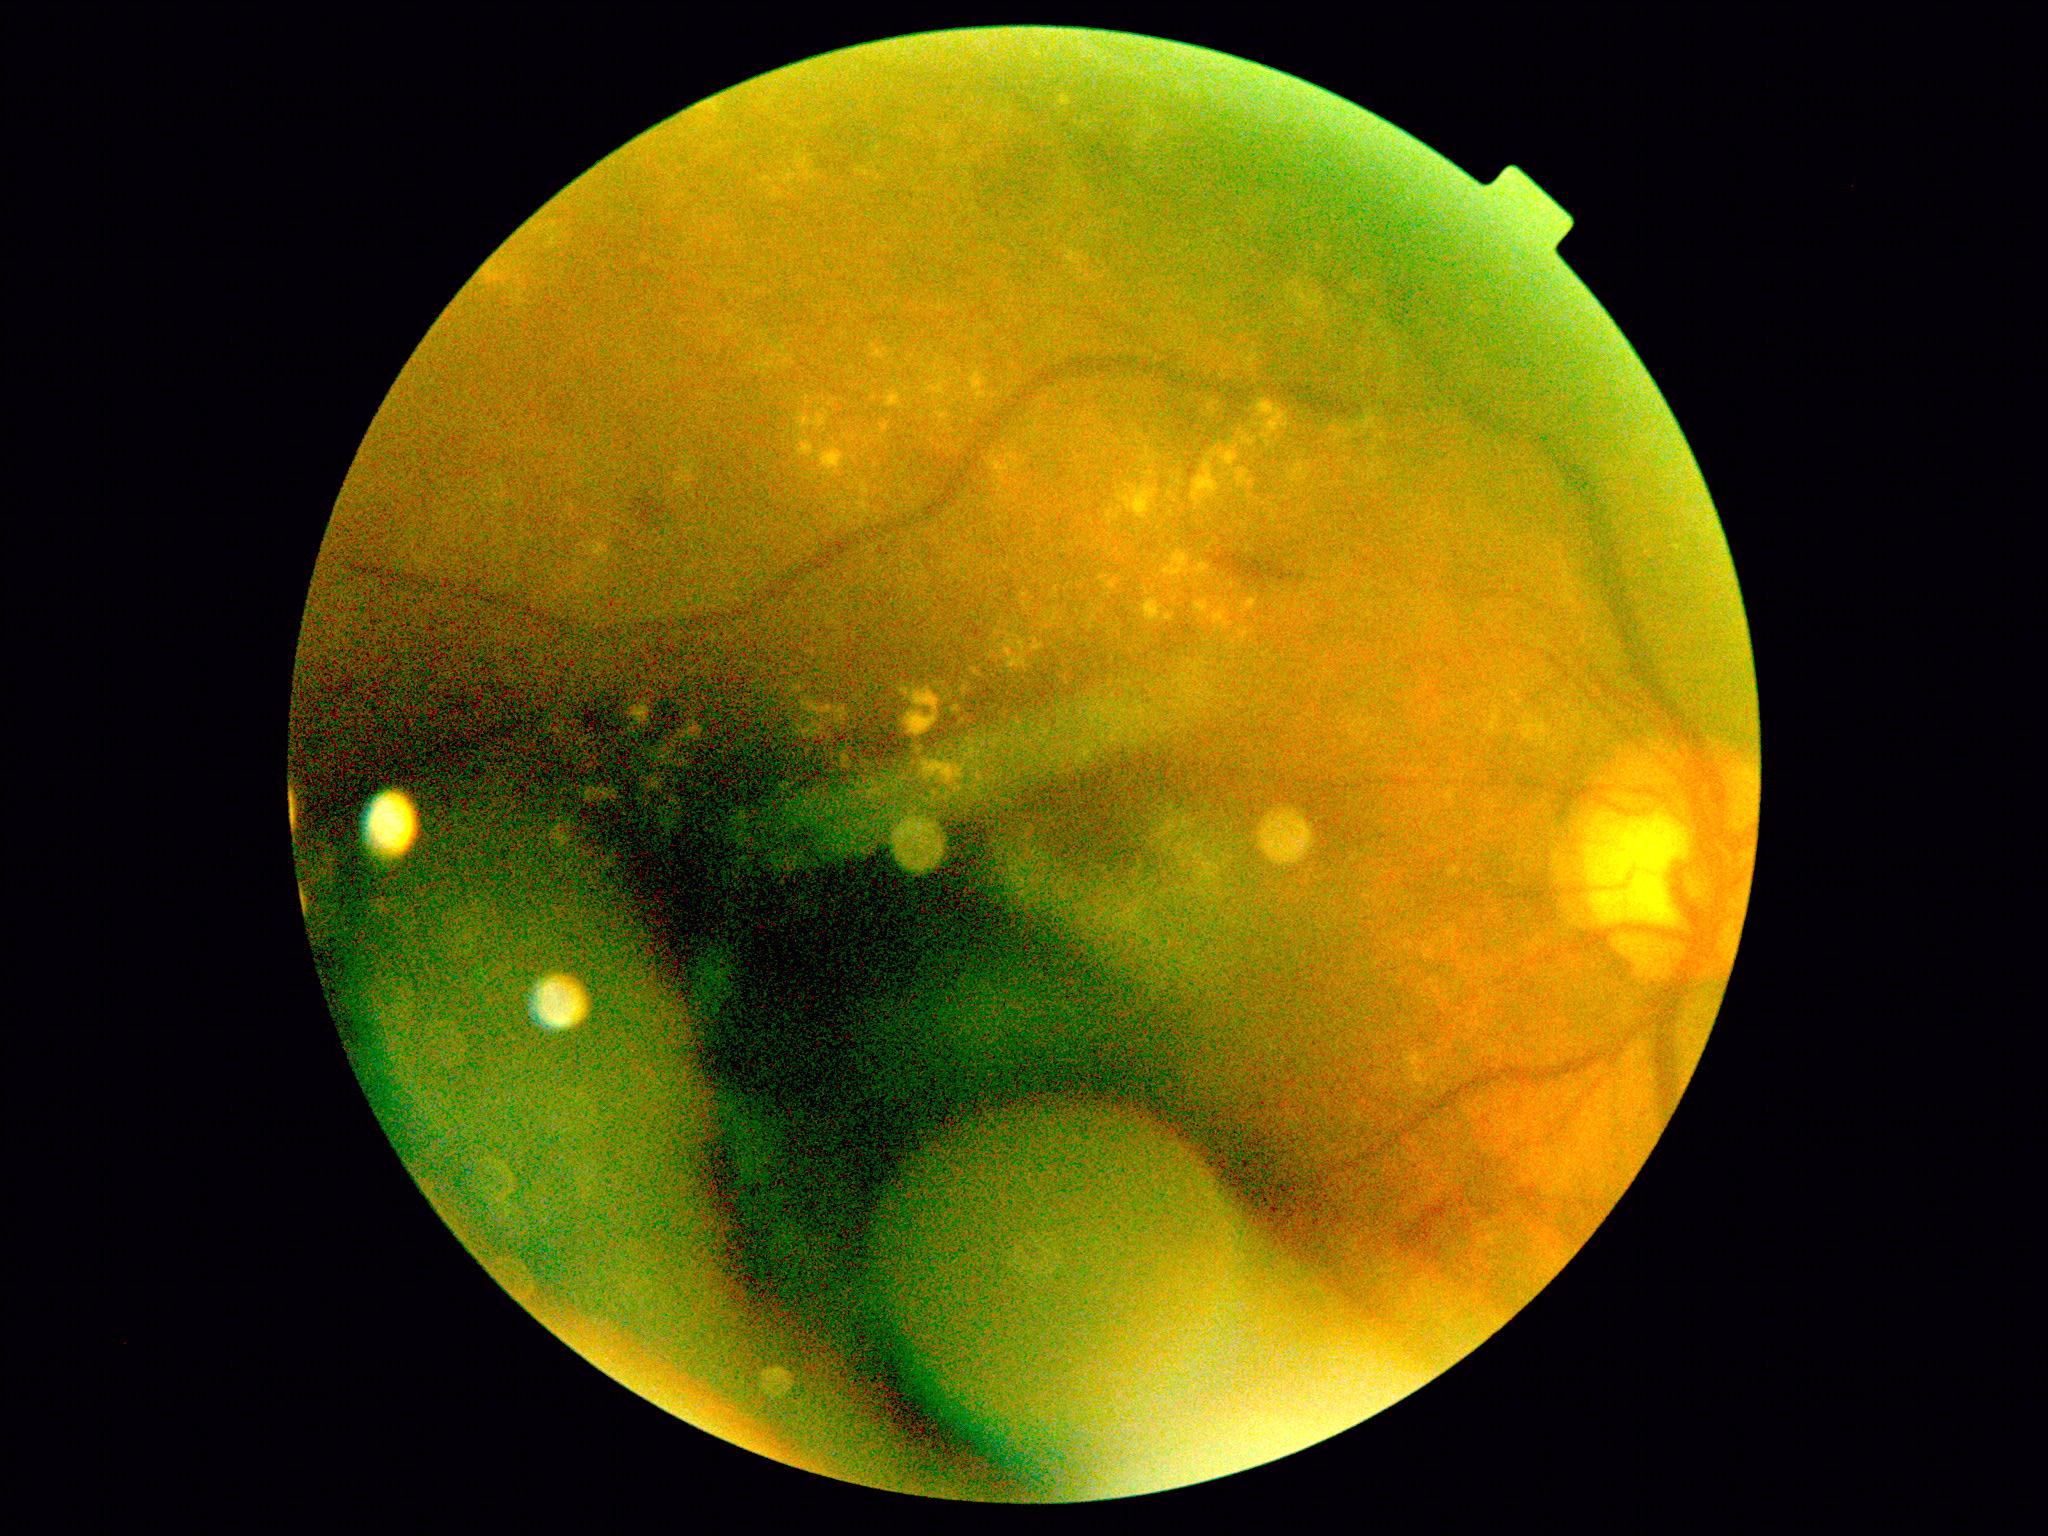
diabetic retinopathy (DR) = moderate NPDR (grade 2).